Davis DR grading · camera: NIDEK AFC-230.
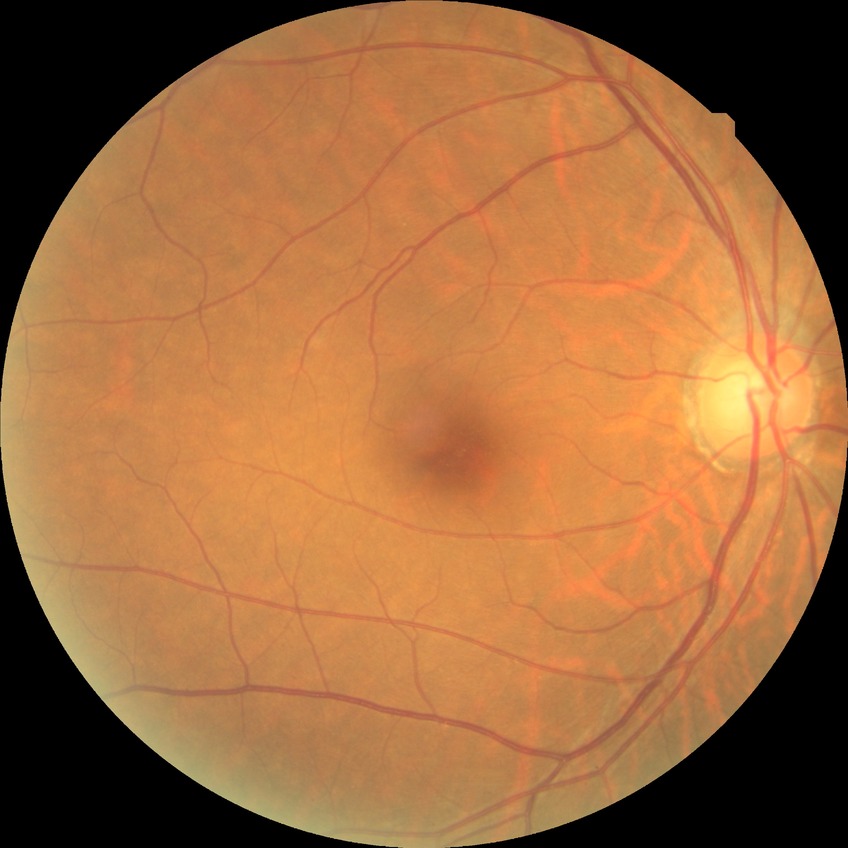
Davis grading is no diabetic retinopathy.